45° FOV, NIDEK AFC-230 fundus camera.
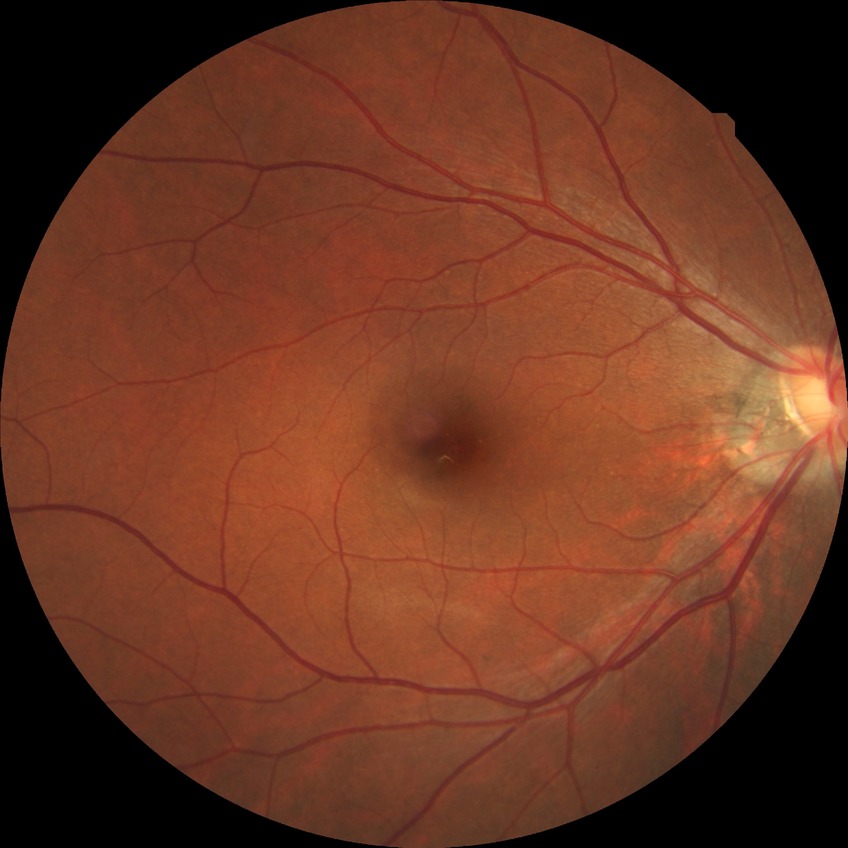

Diabetic retinopathy (DR) is SDR (simple diabetic retinopathy).